Color fundus image; captured on a Nidek AFC-330 fundus camera; non-mydriatic fundus camera
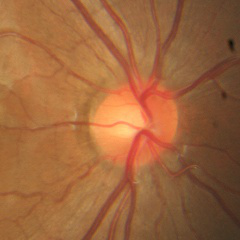
Diagnosis: no glaucomatous optic neuropathy.